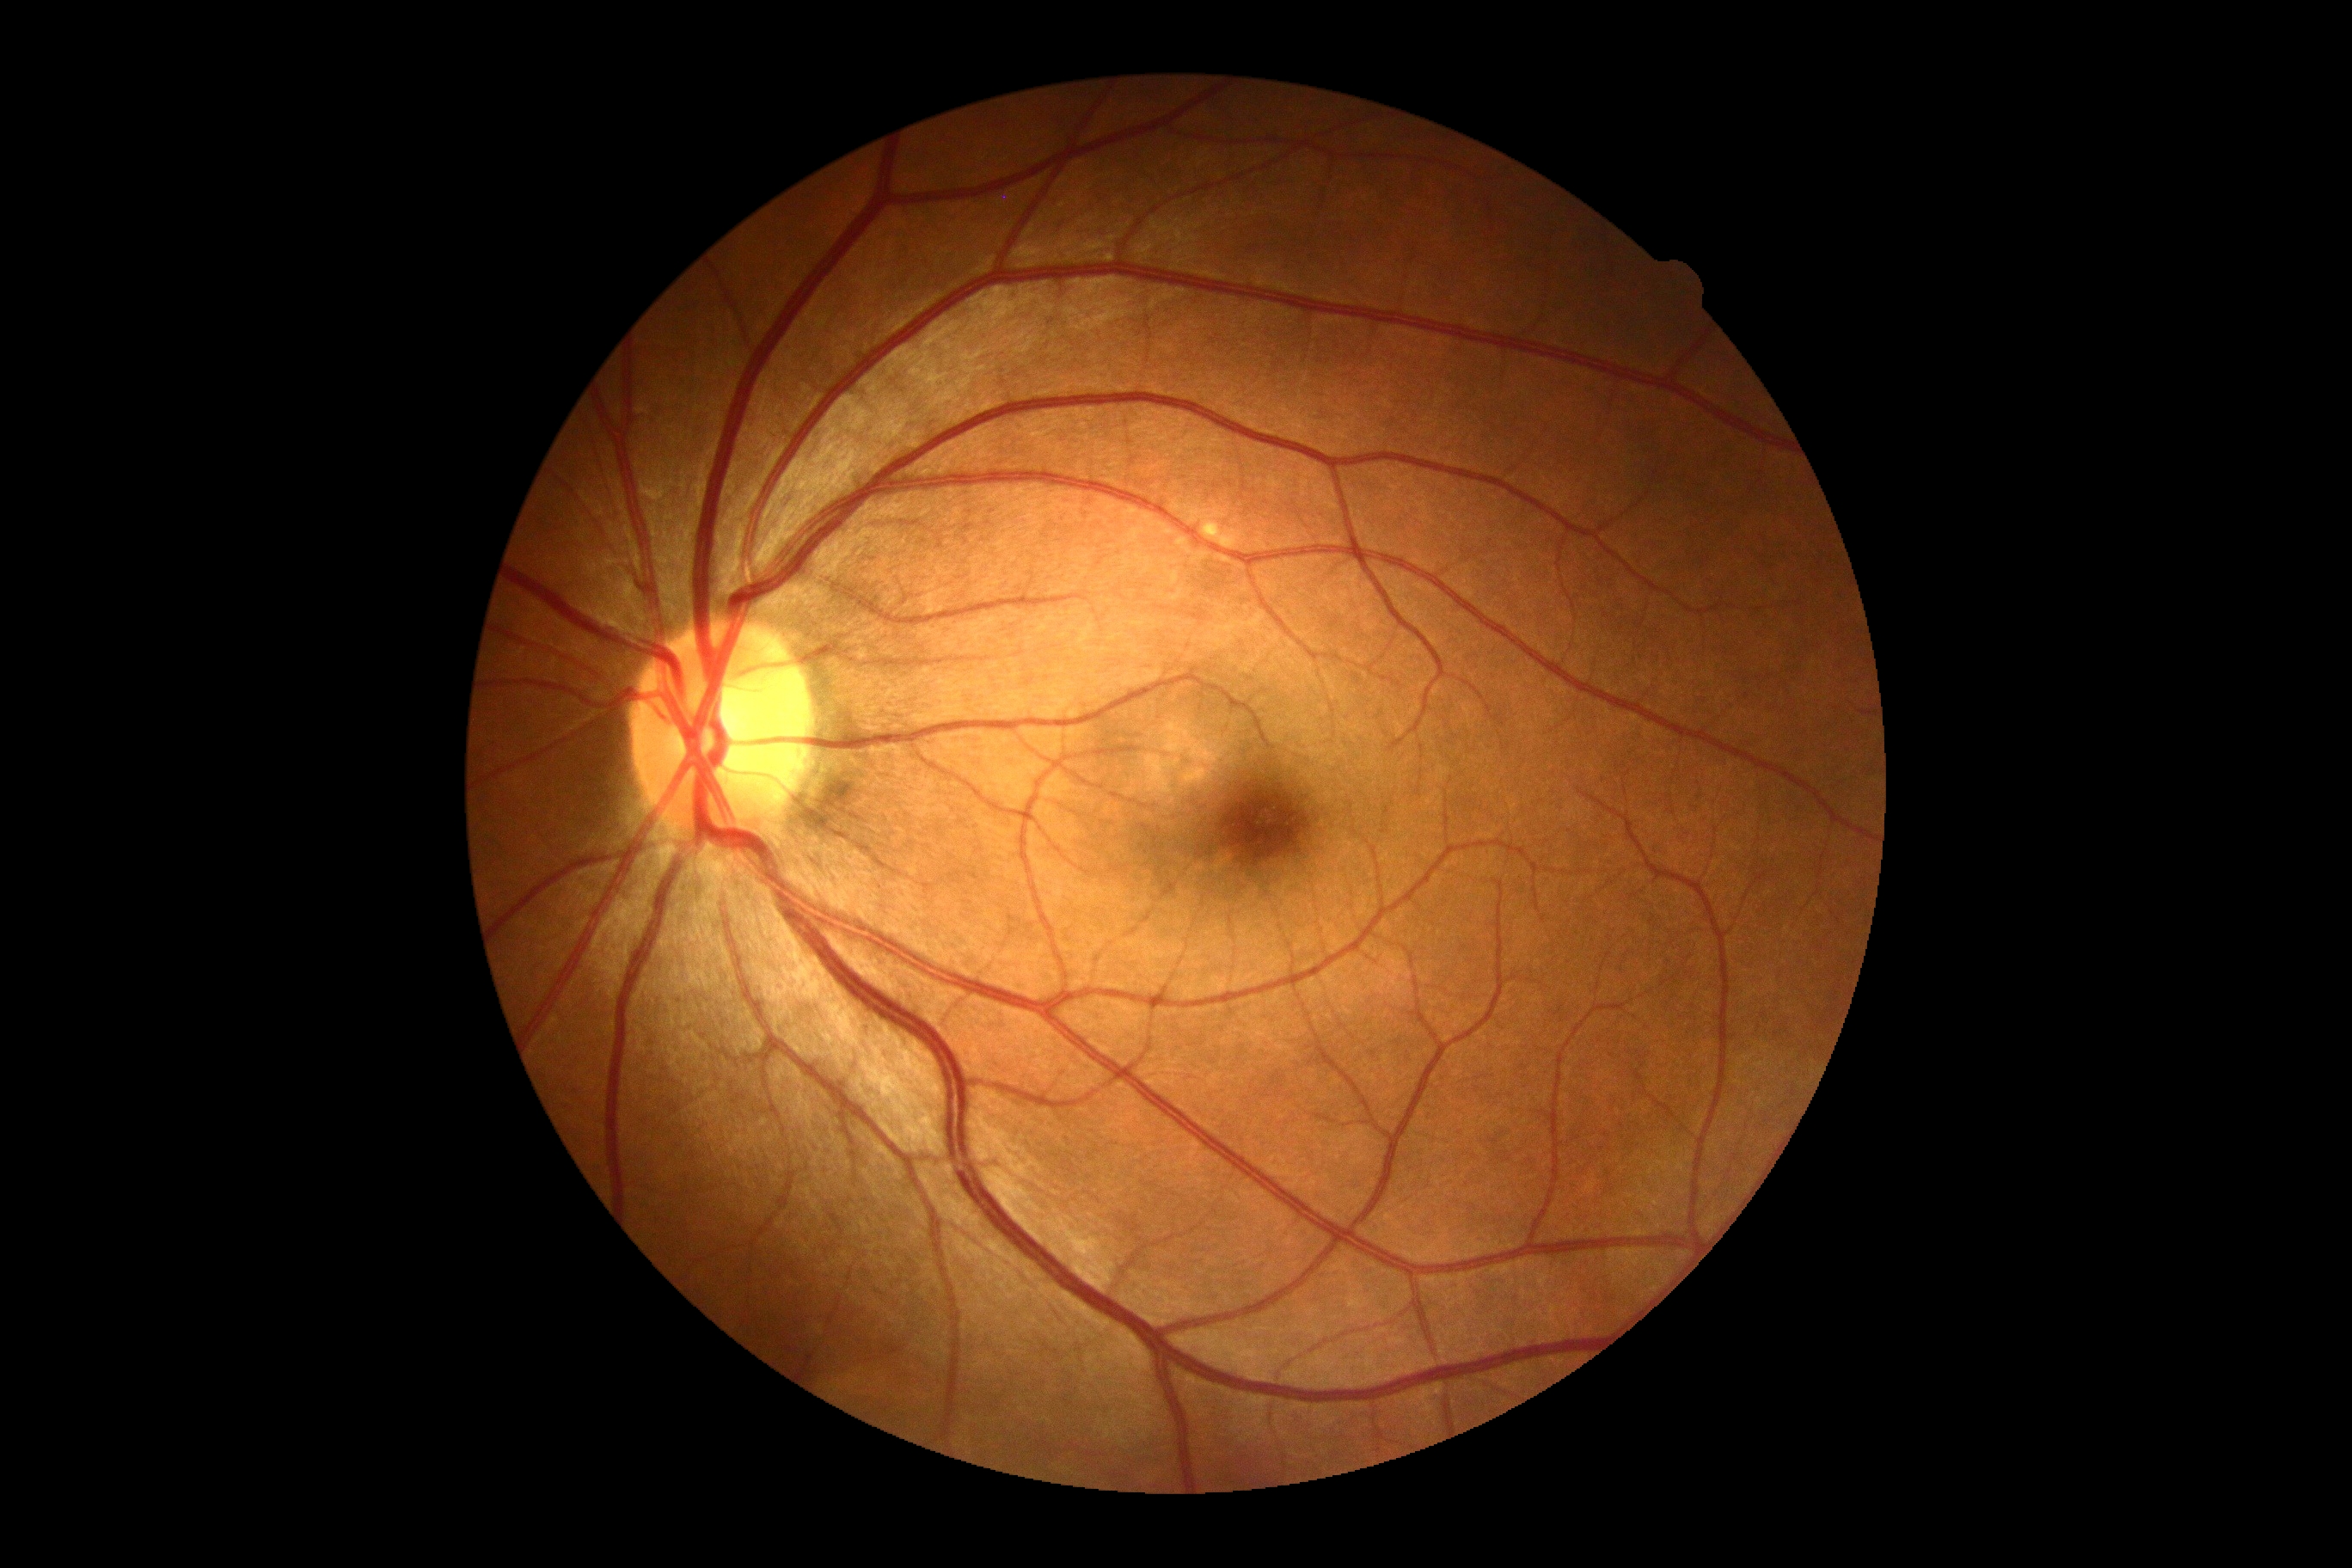

DR grade: no apparent retinopathy (0).